FOV: 45 degrees · NIDEK AFC-230 fundus camera · 848x848px: 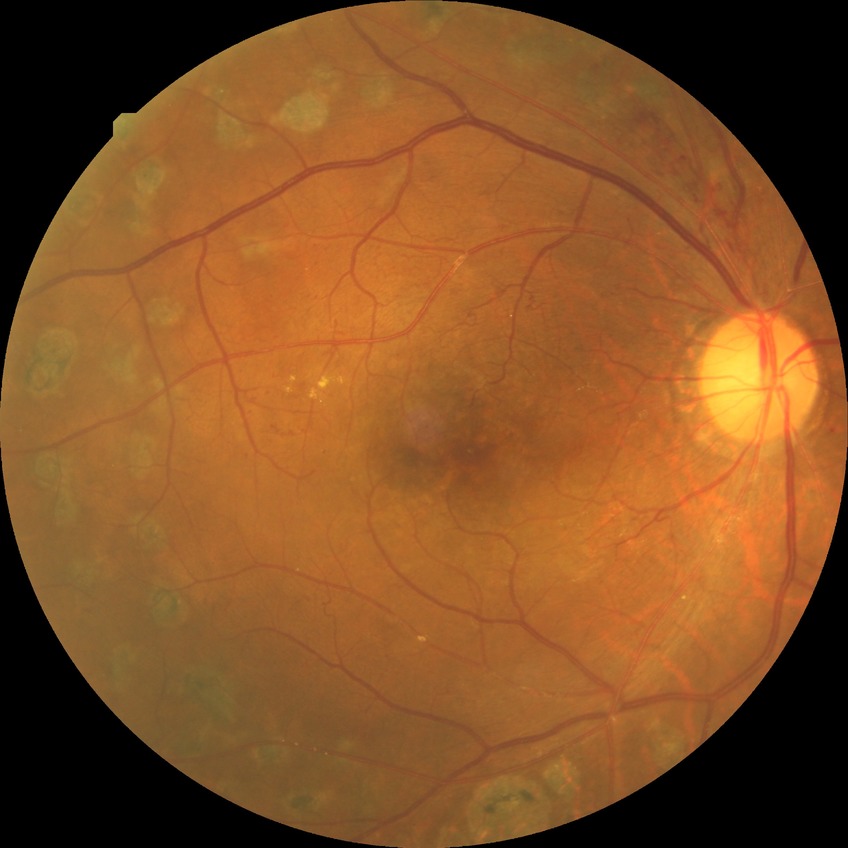
  davis_grade: proliferative diabetic retinopathy